Modified Davis classification. 45 degree fundus photograph. Nonmydriatic fundus photograph:
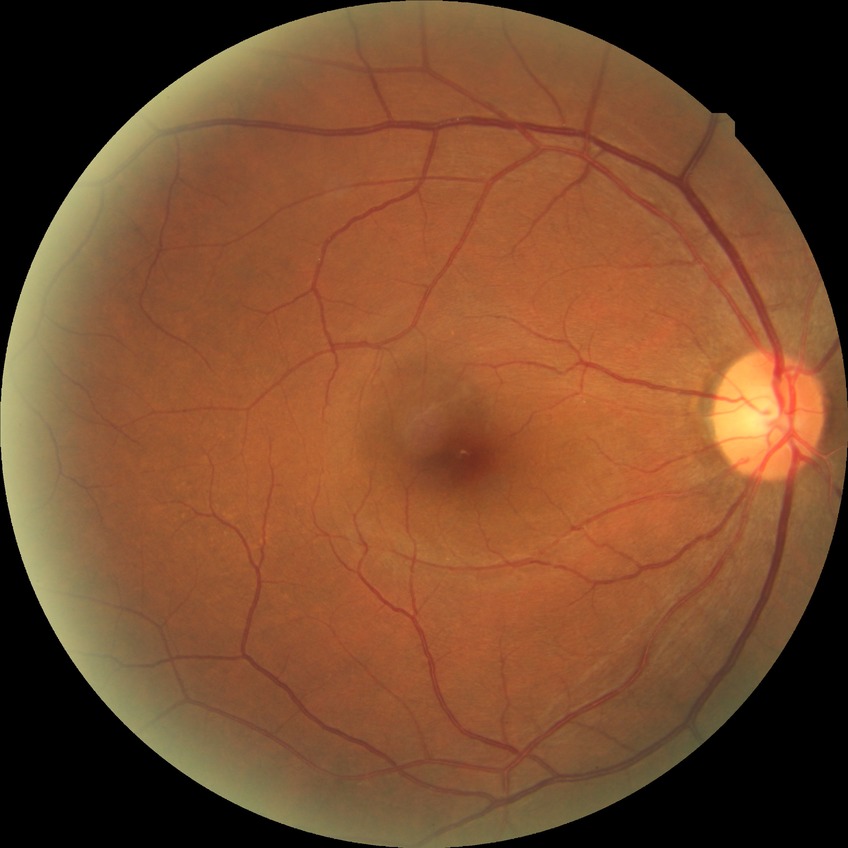

Diabetic retinopathy (DR) is no diabetic retinopathy (NDR).